1932 by 1932 pixels · captured on a Topcon TRC-NW8 fundus camera
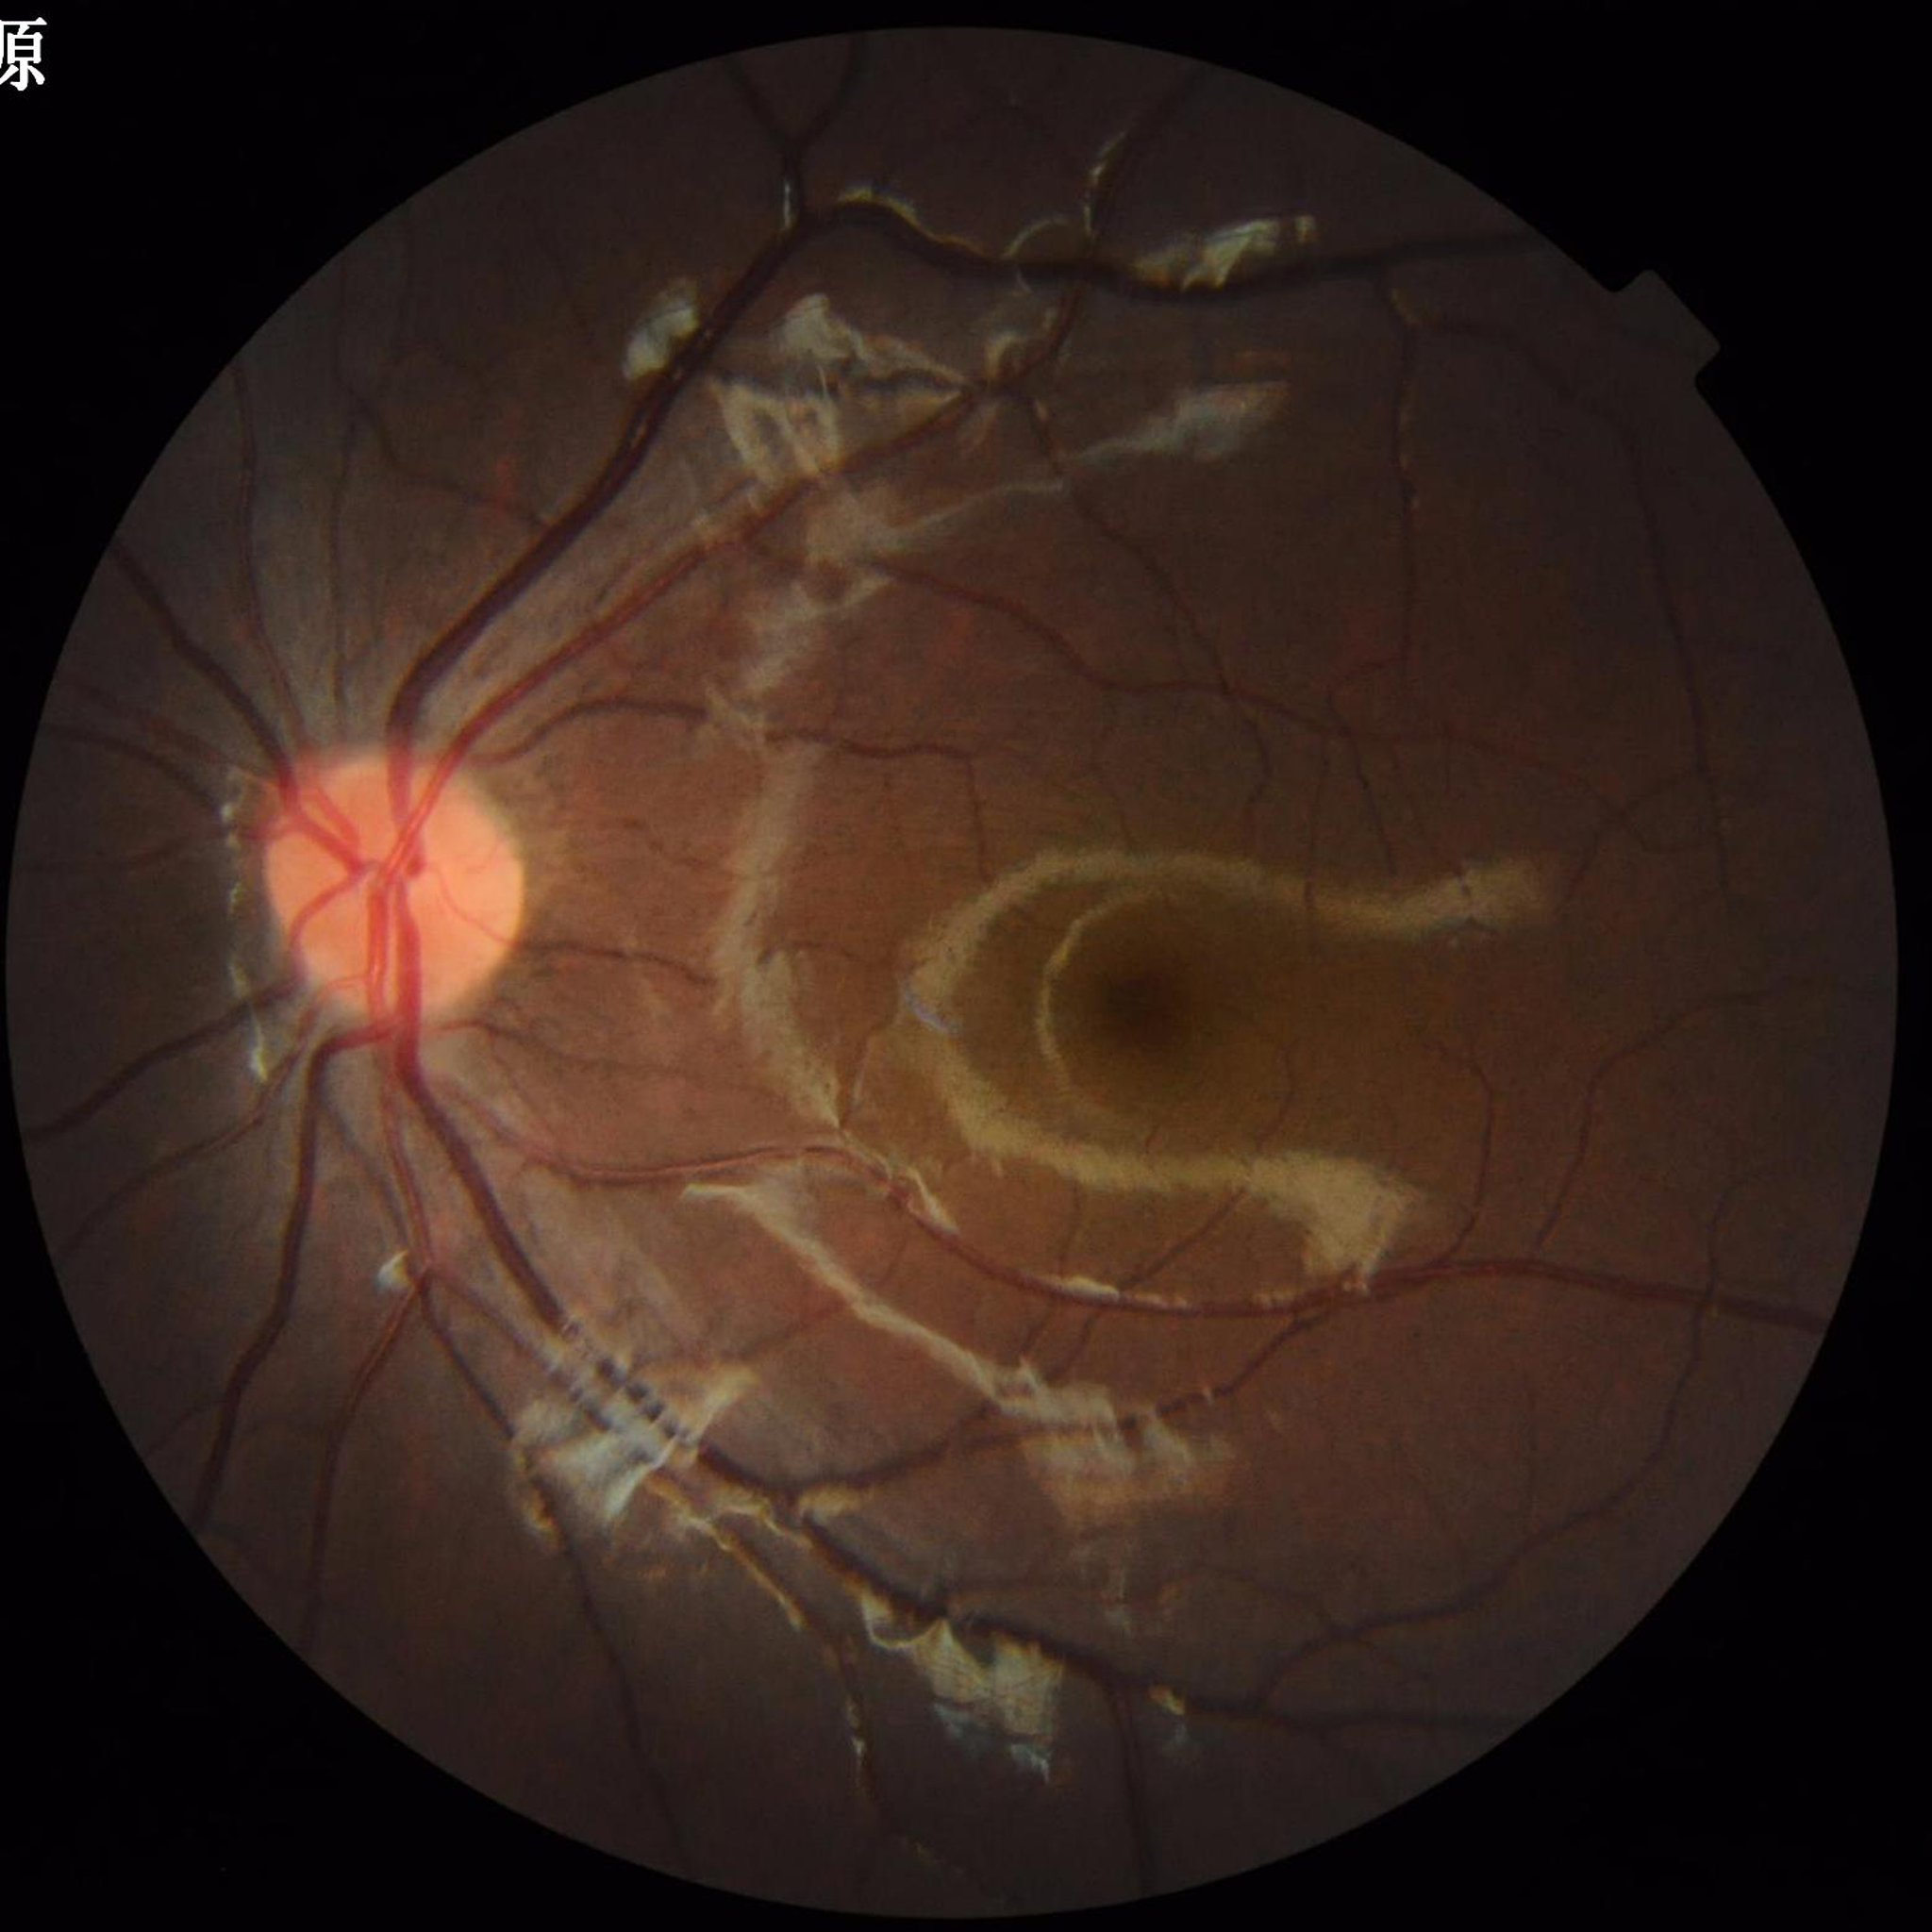 Quality: illumination/color distortion present, no blur, contrast adequate; Condition: control (no AMD/DR/glaucoma).